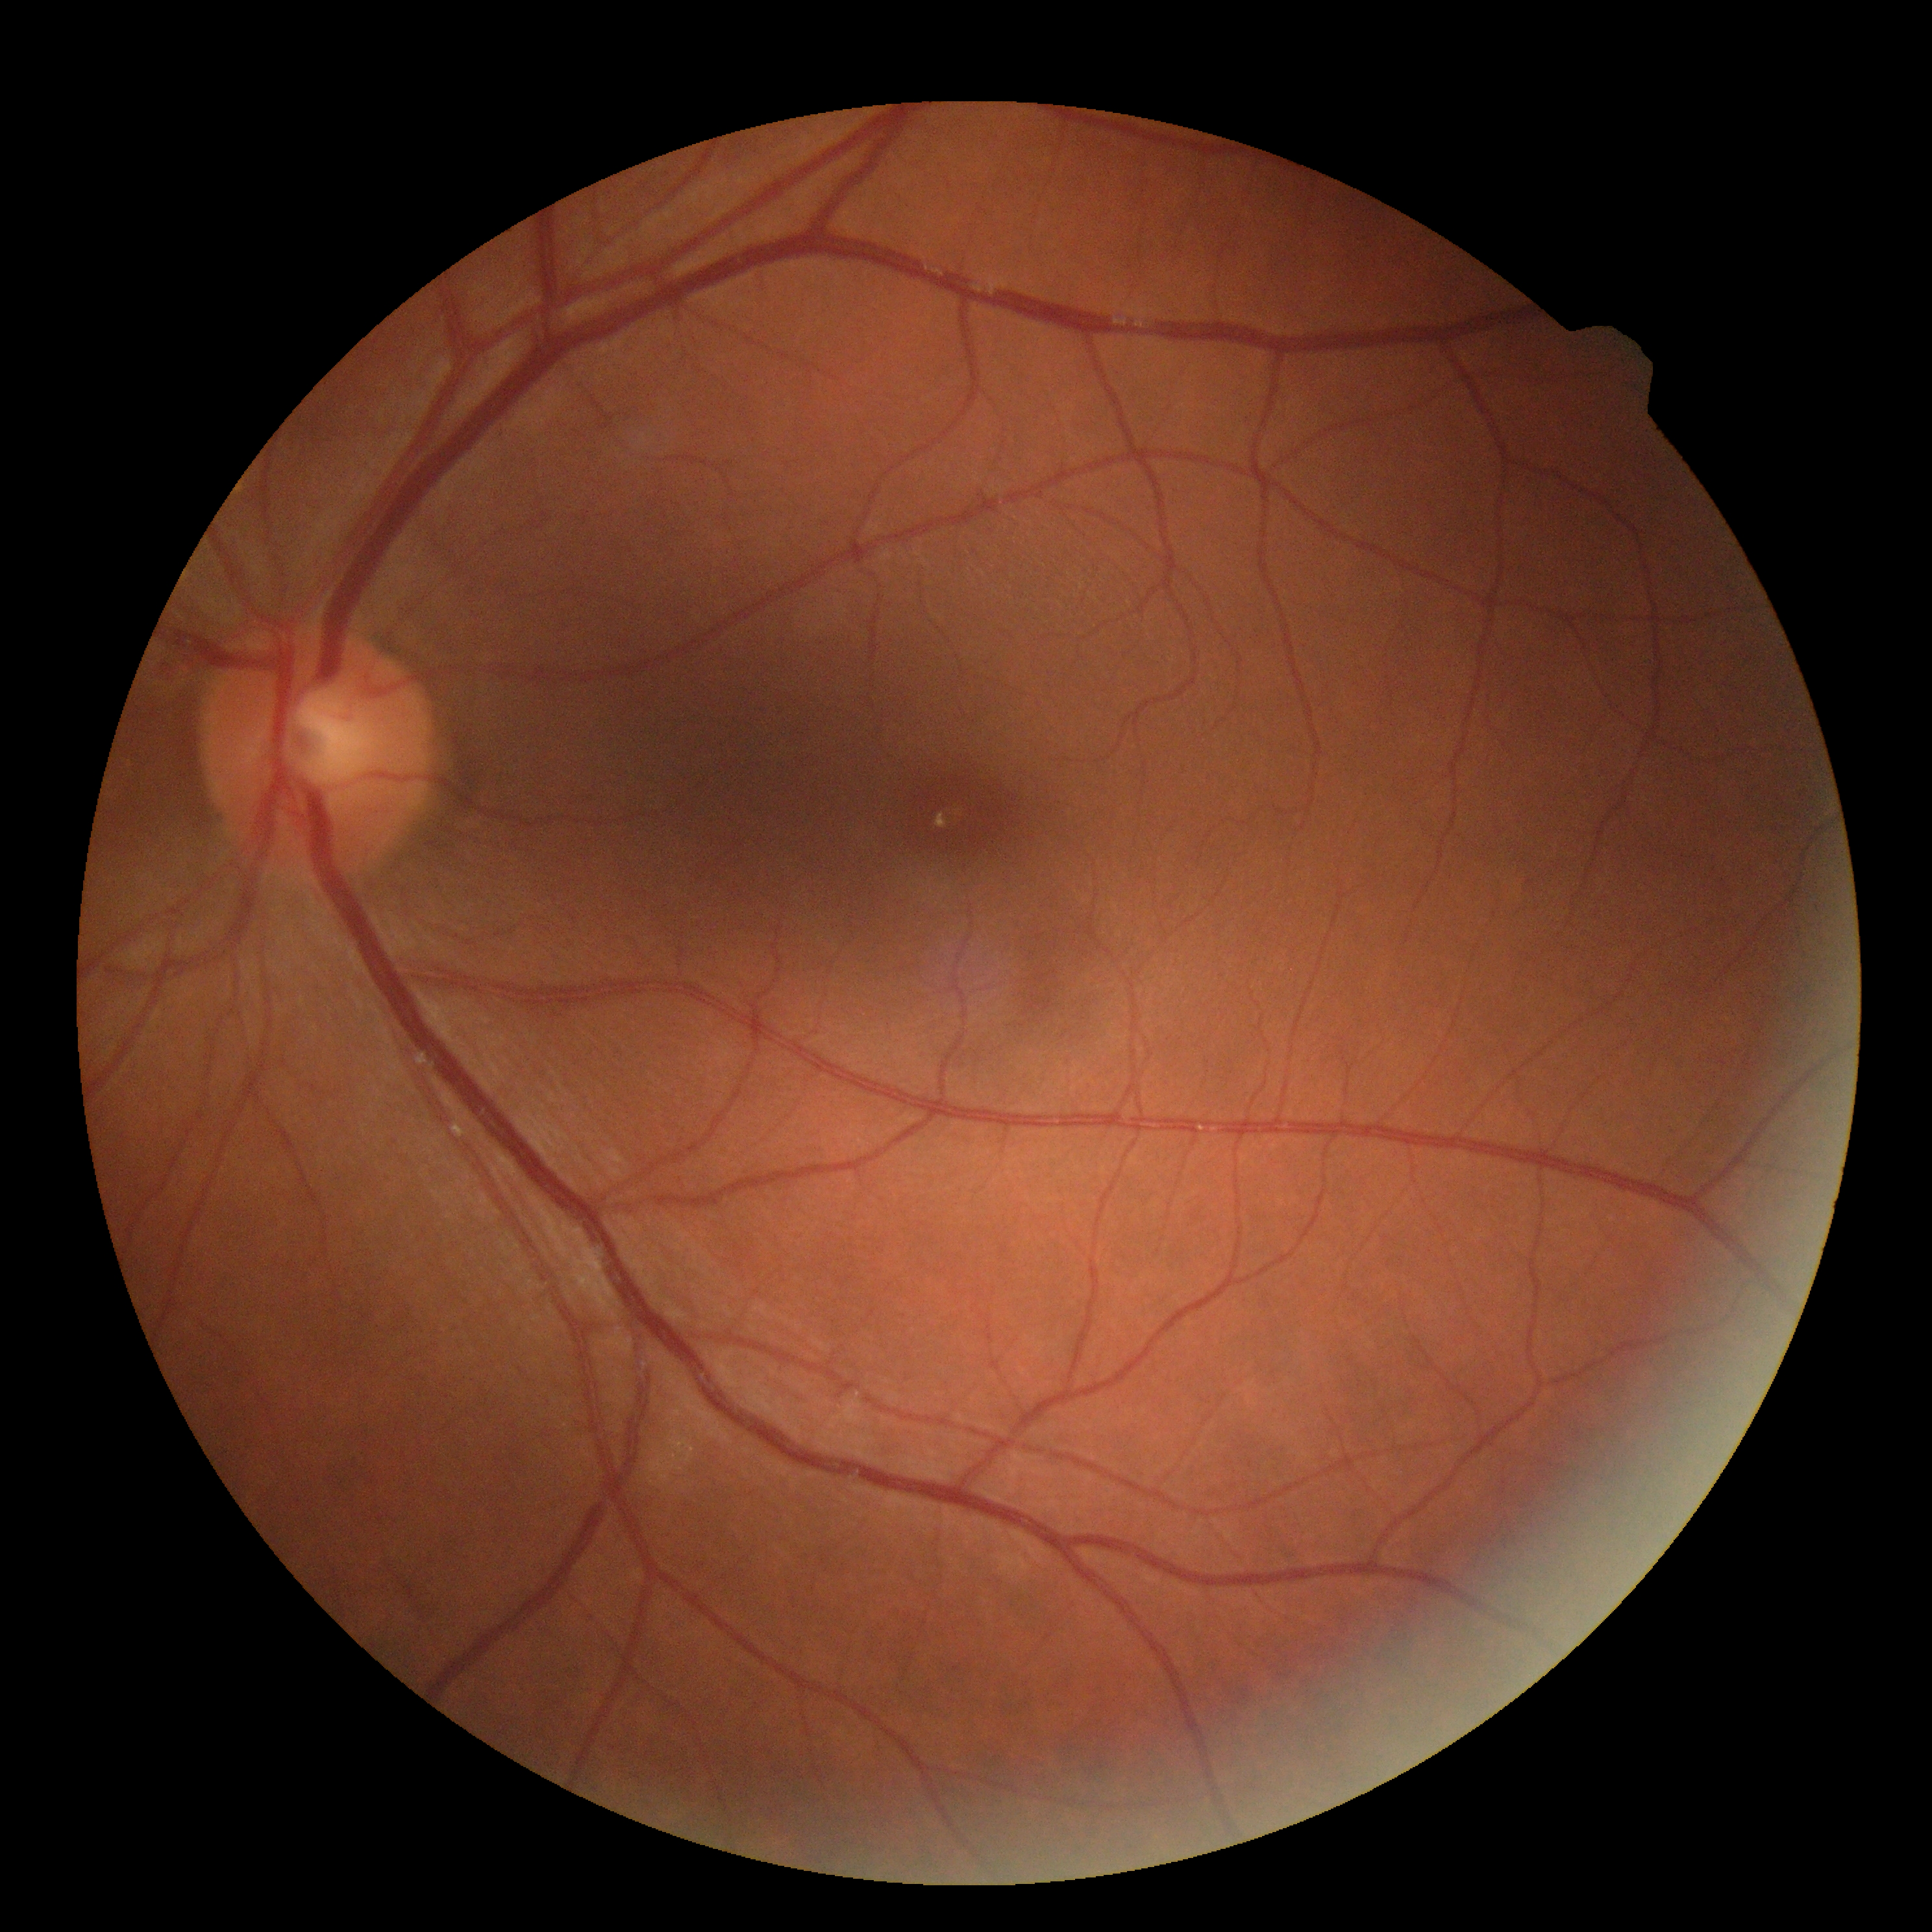

No apparent diabetic retinopathy. DR severity is grade 0 — no visible signs of diabetic retinopathy.